Wide-field fundus photograph of an infant
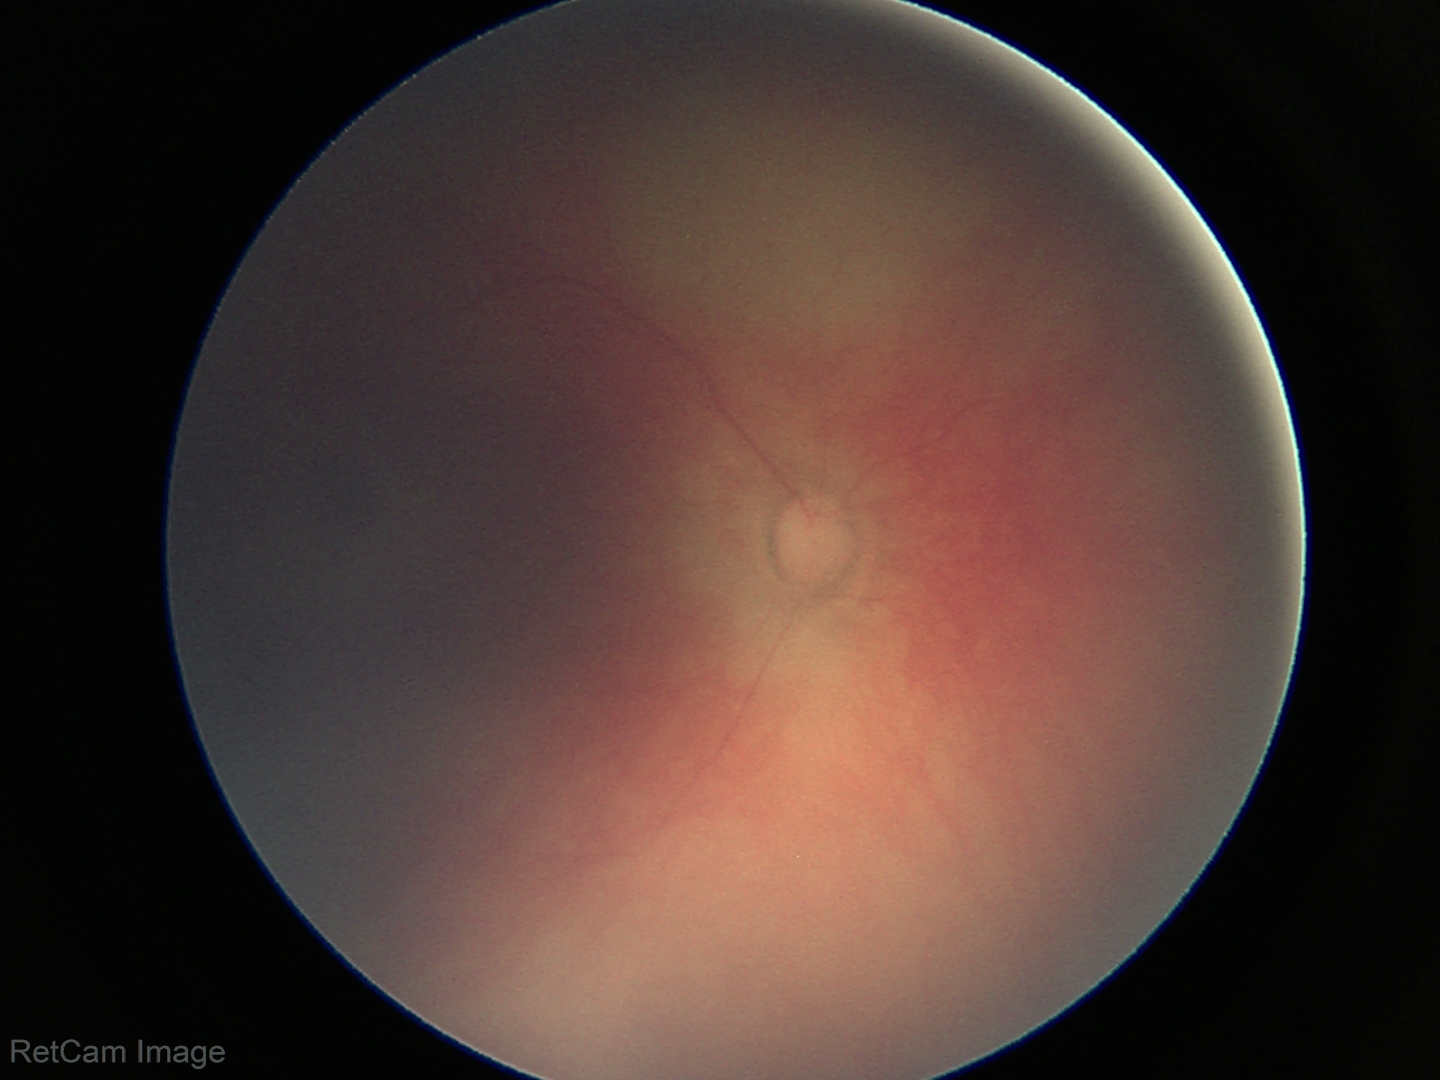 Screening examination with no abnormal retinal findings.